Wide-field fundus image from infant ROP screening · 640x480 · 130° field of view (Clarity RetCam 3): 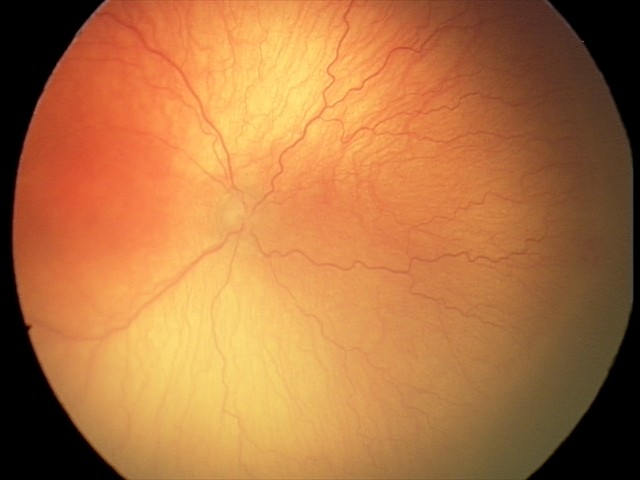
Diagnosis: A-ROP (aggressive ROP).